2352 x 1568 pixels. CFP.
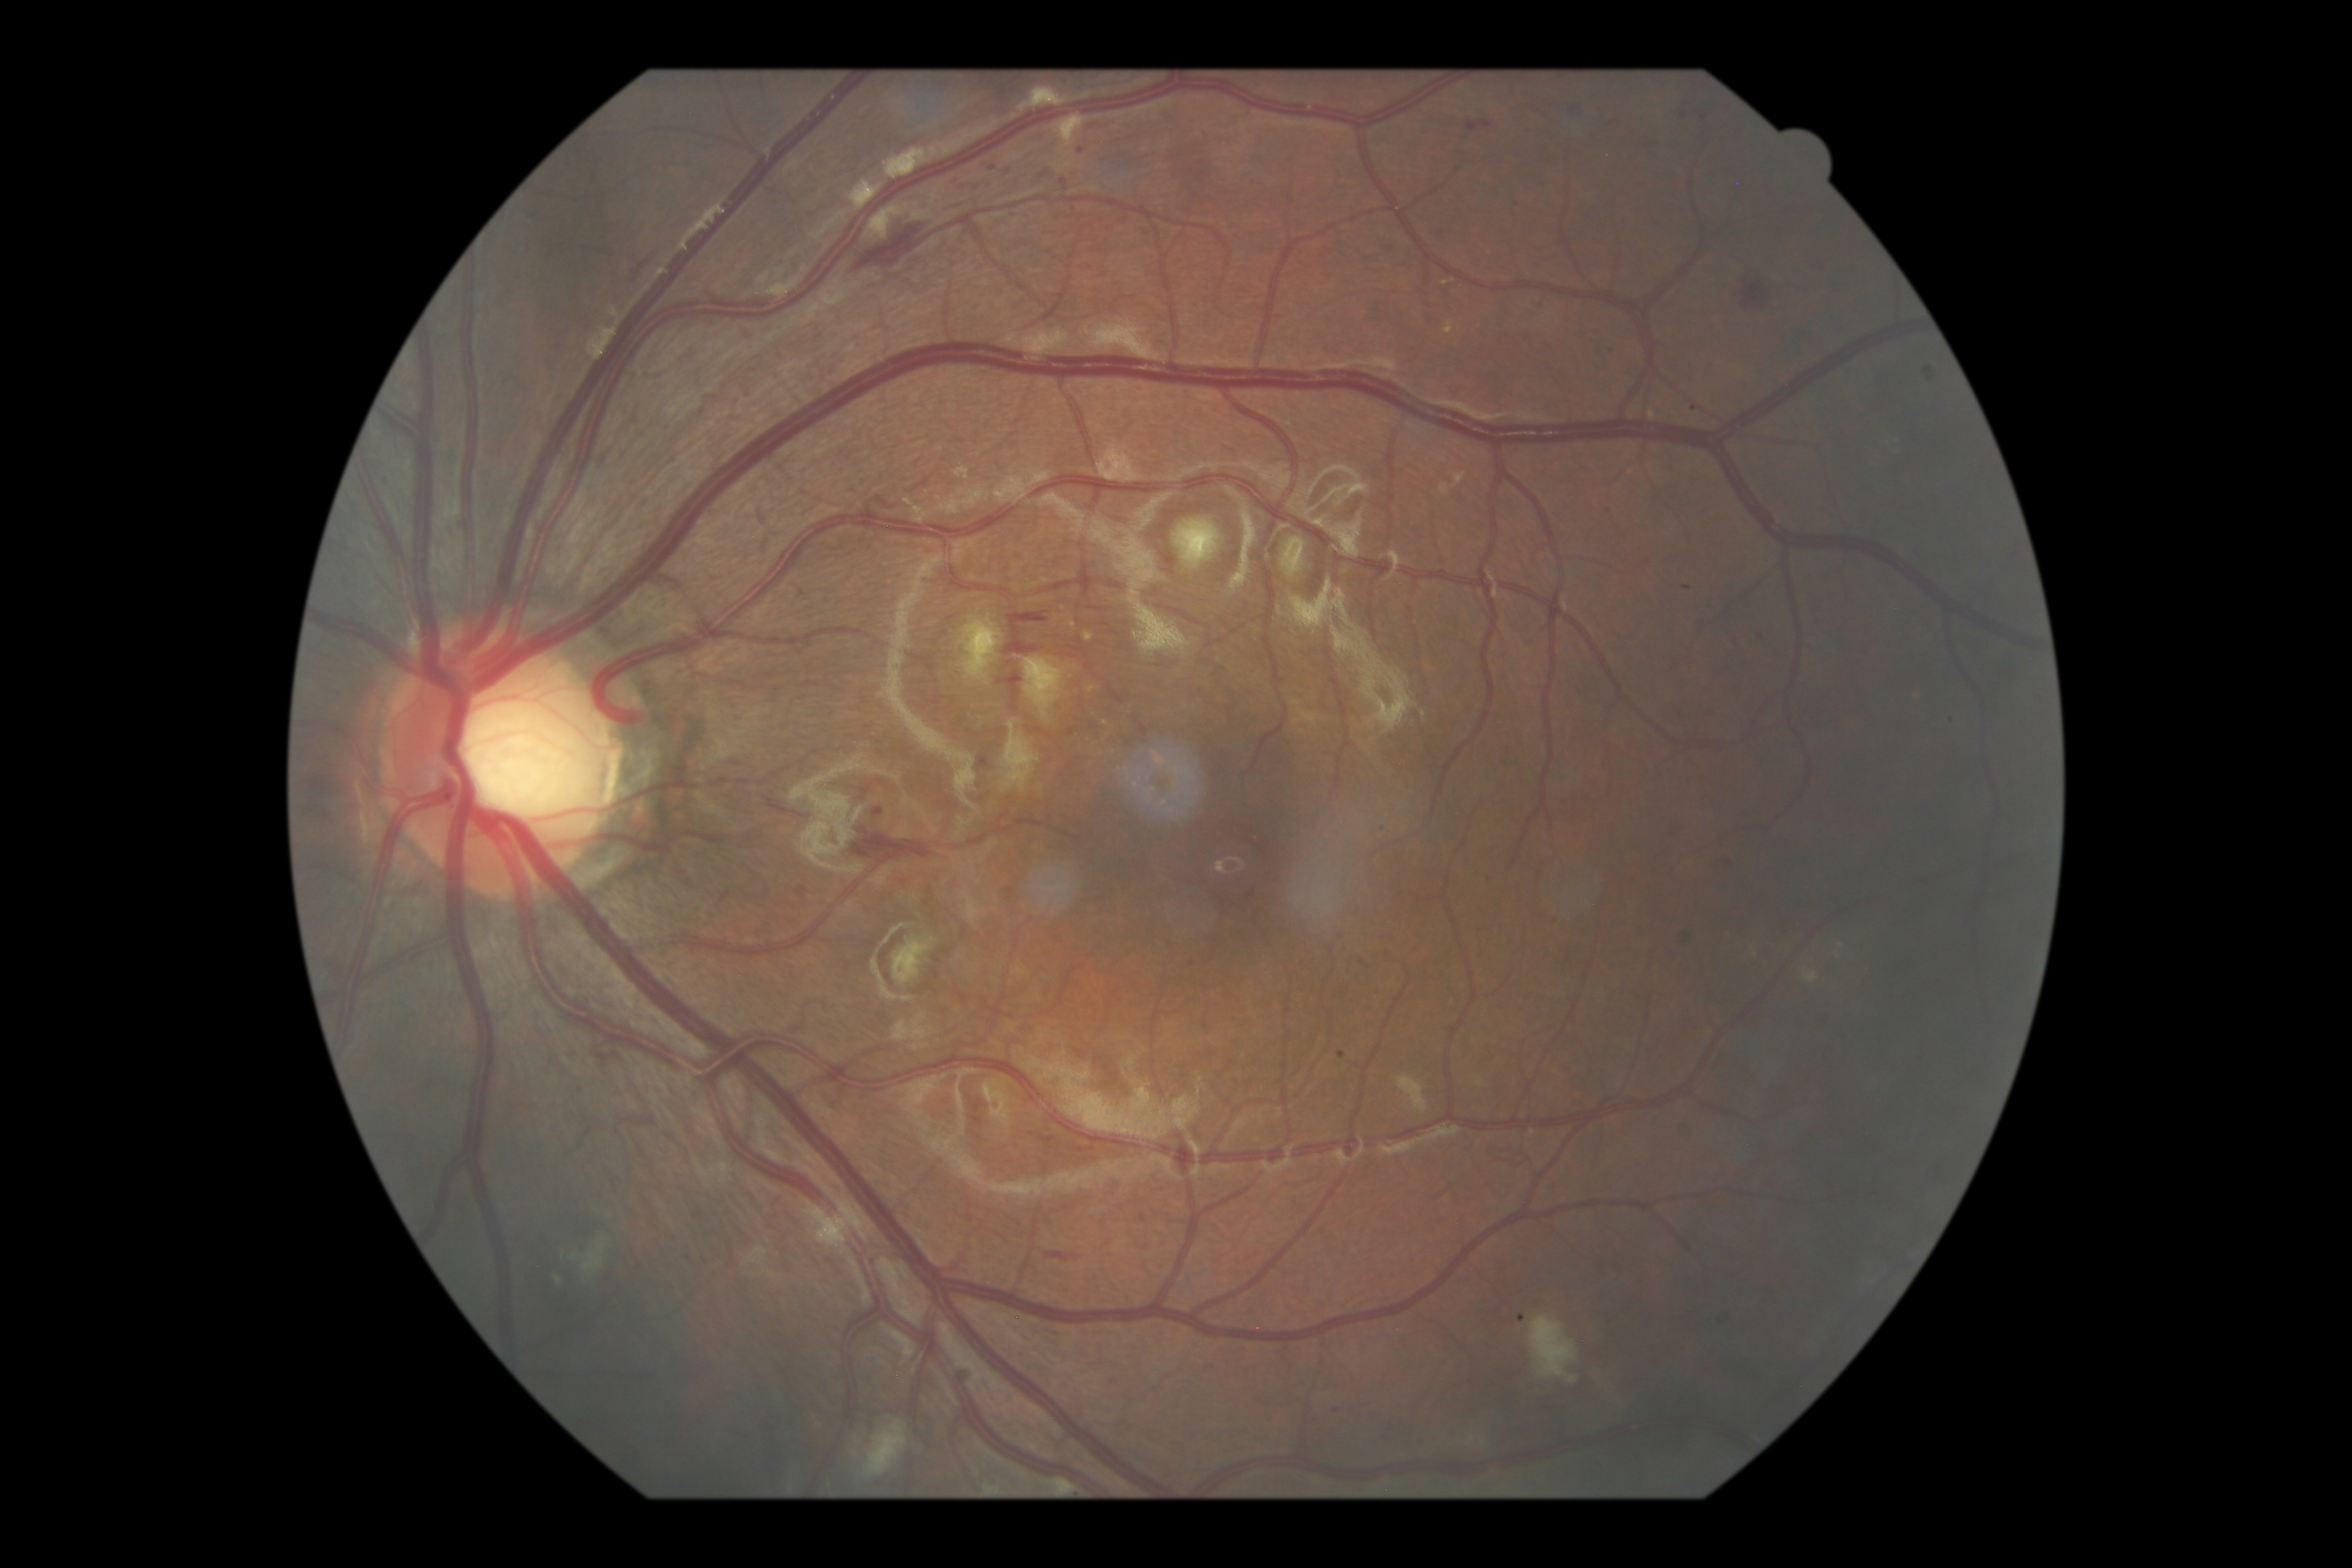 Diabetic retinopathy grade is moderate non-proliferative diabetic retinopathy (2).